FOV: 45 degrees.
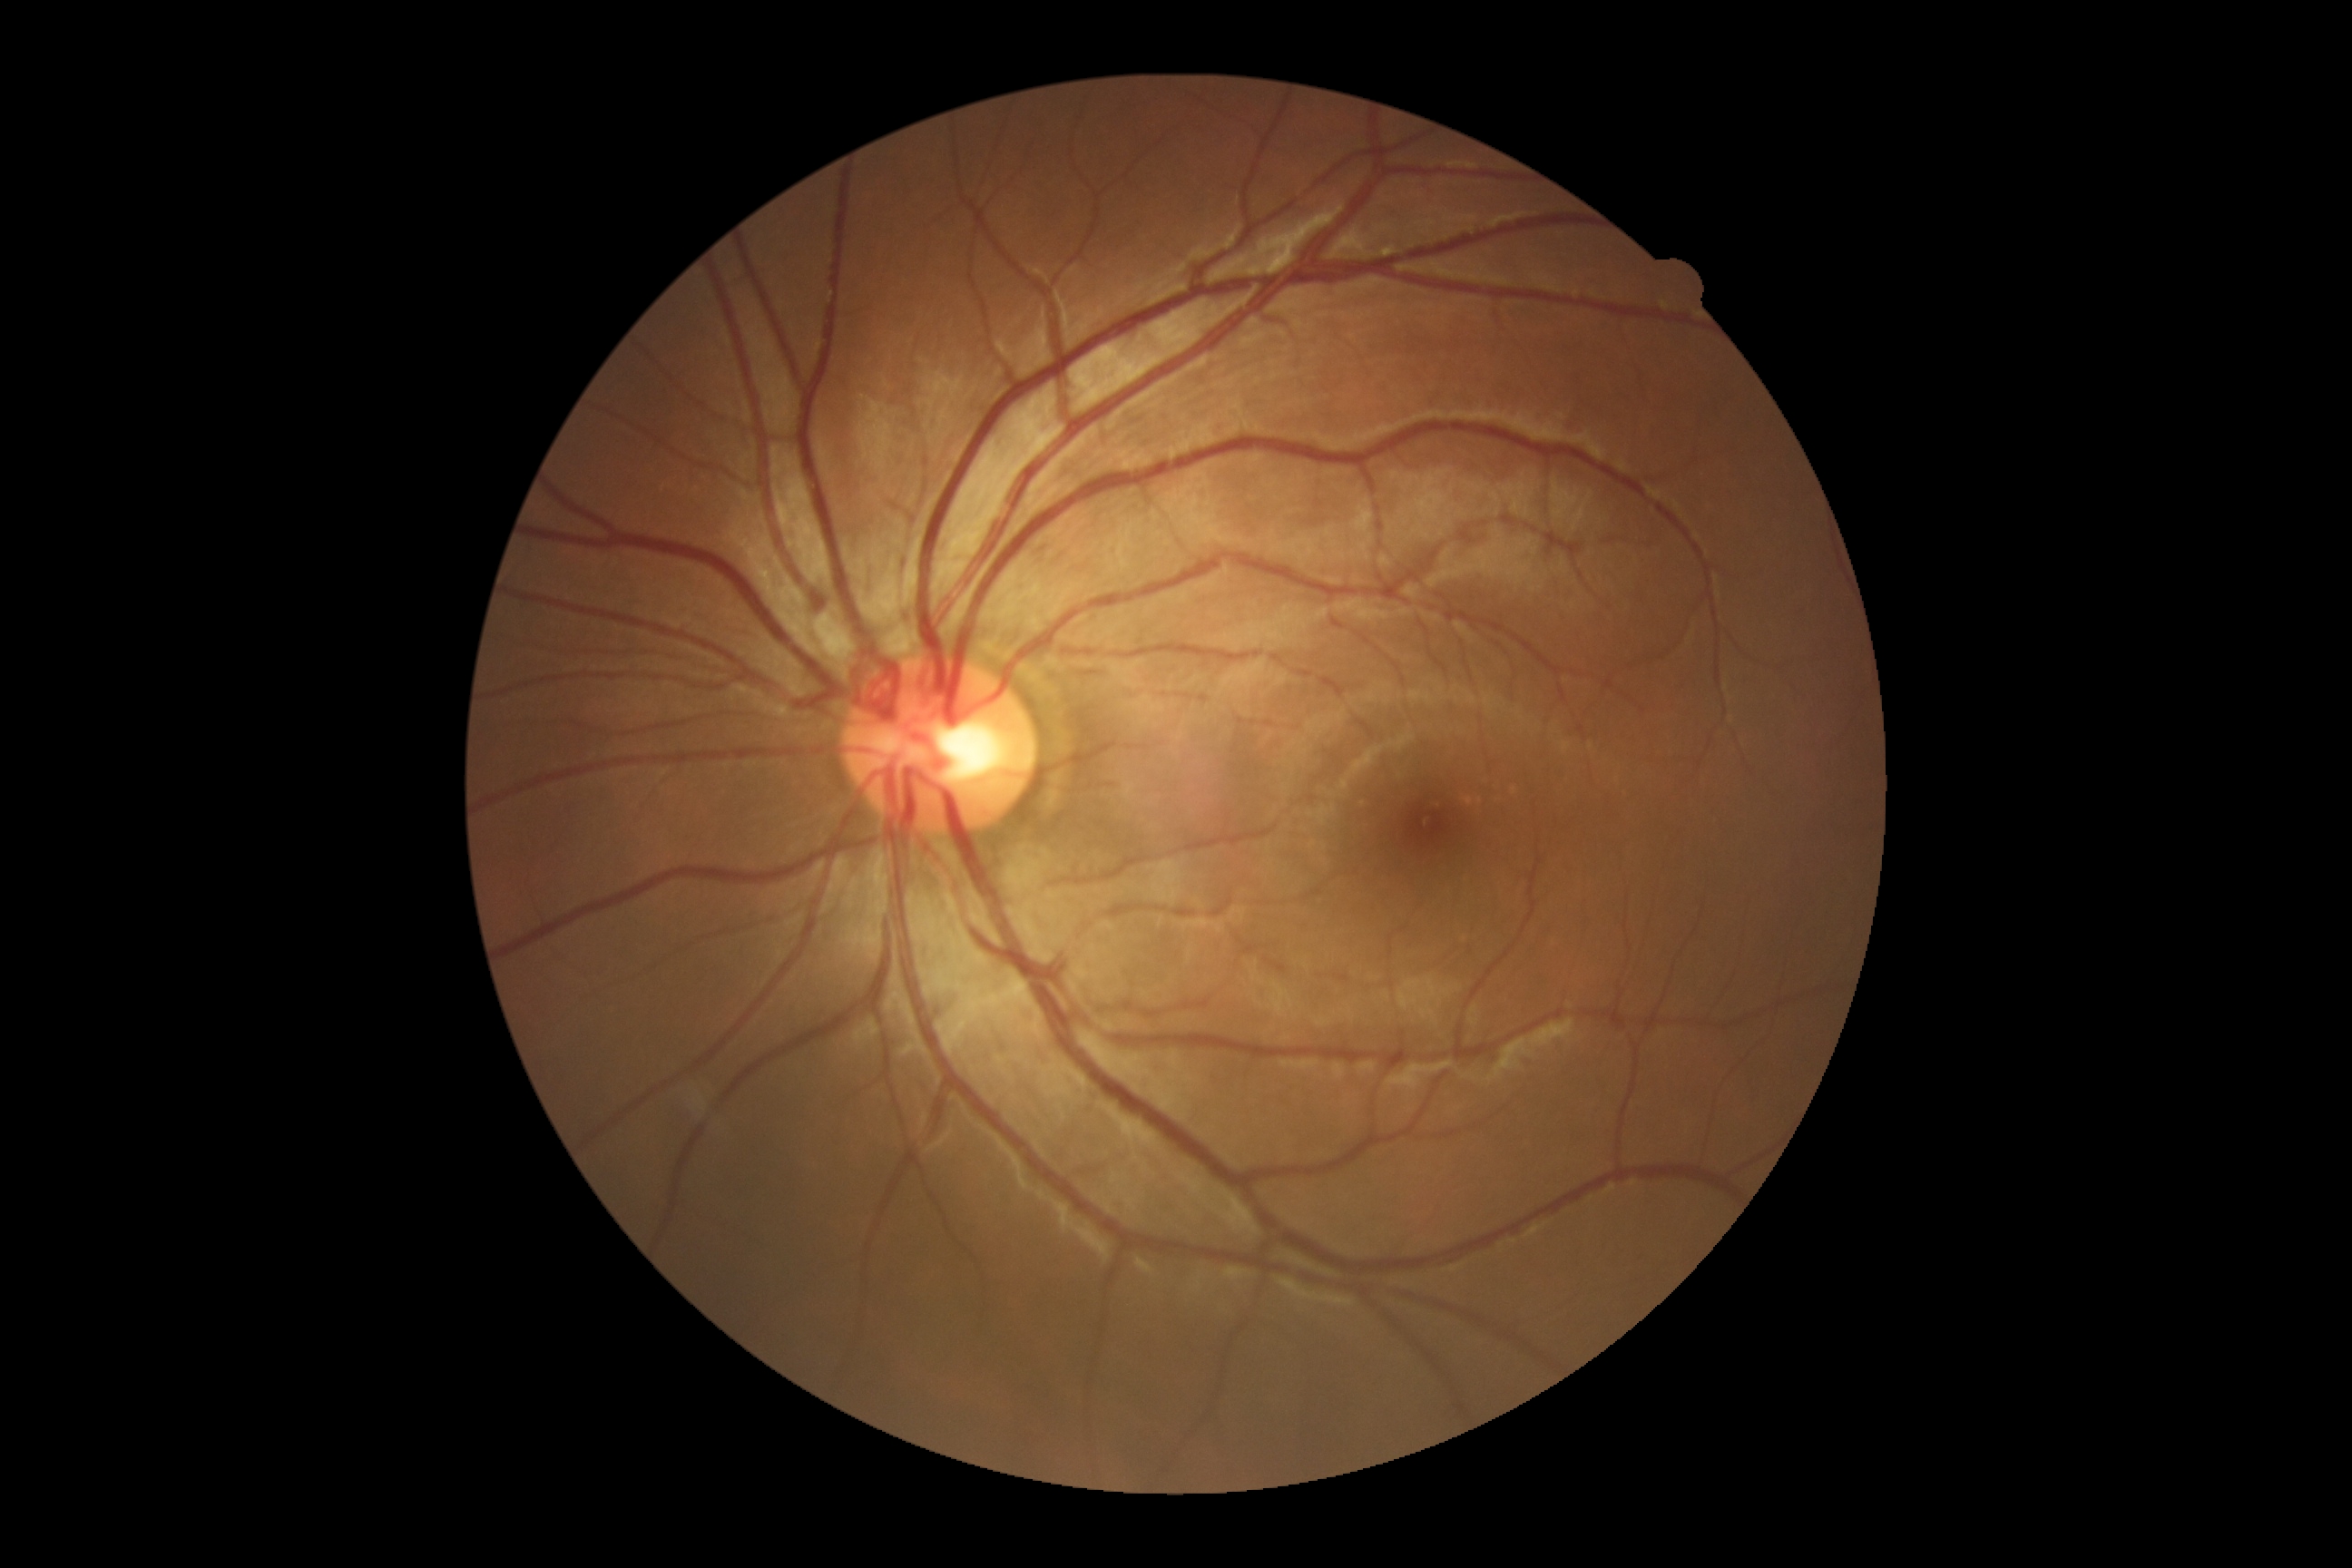
DR grade: no apparent retinopathy (0).